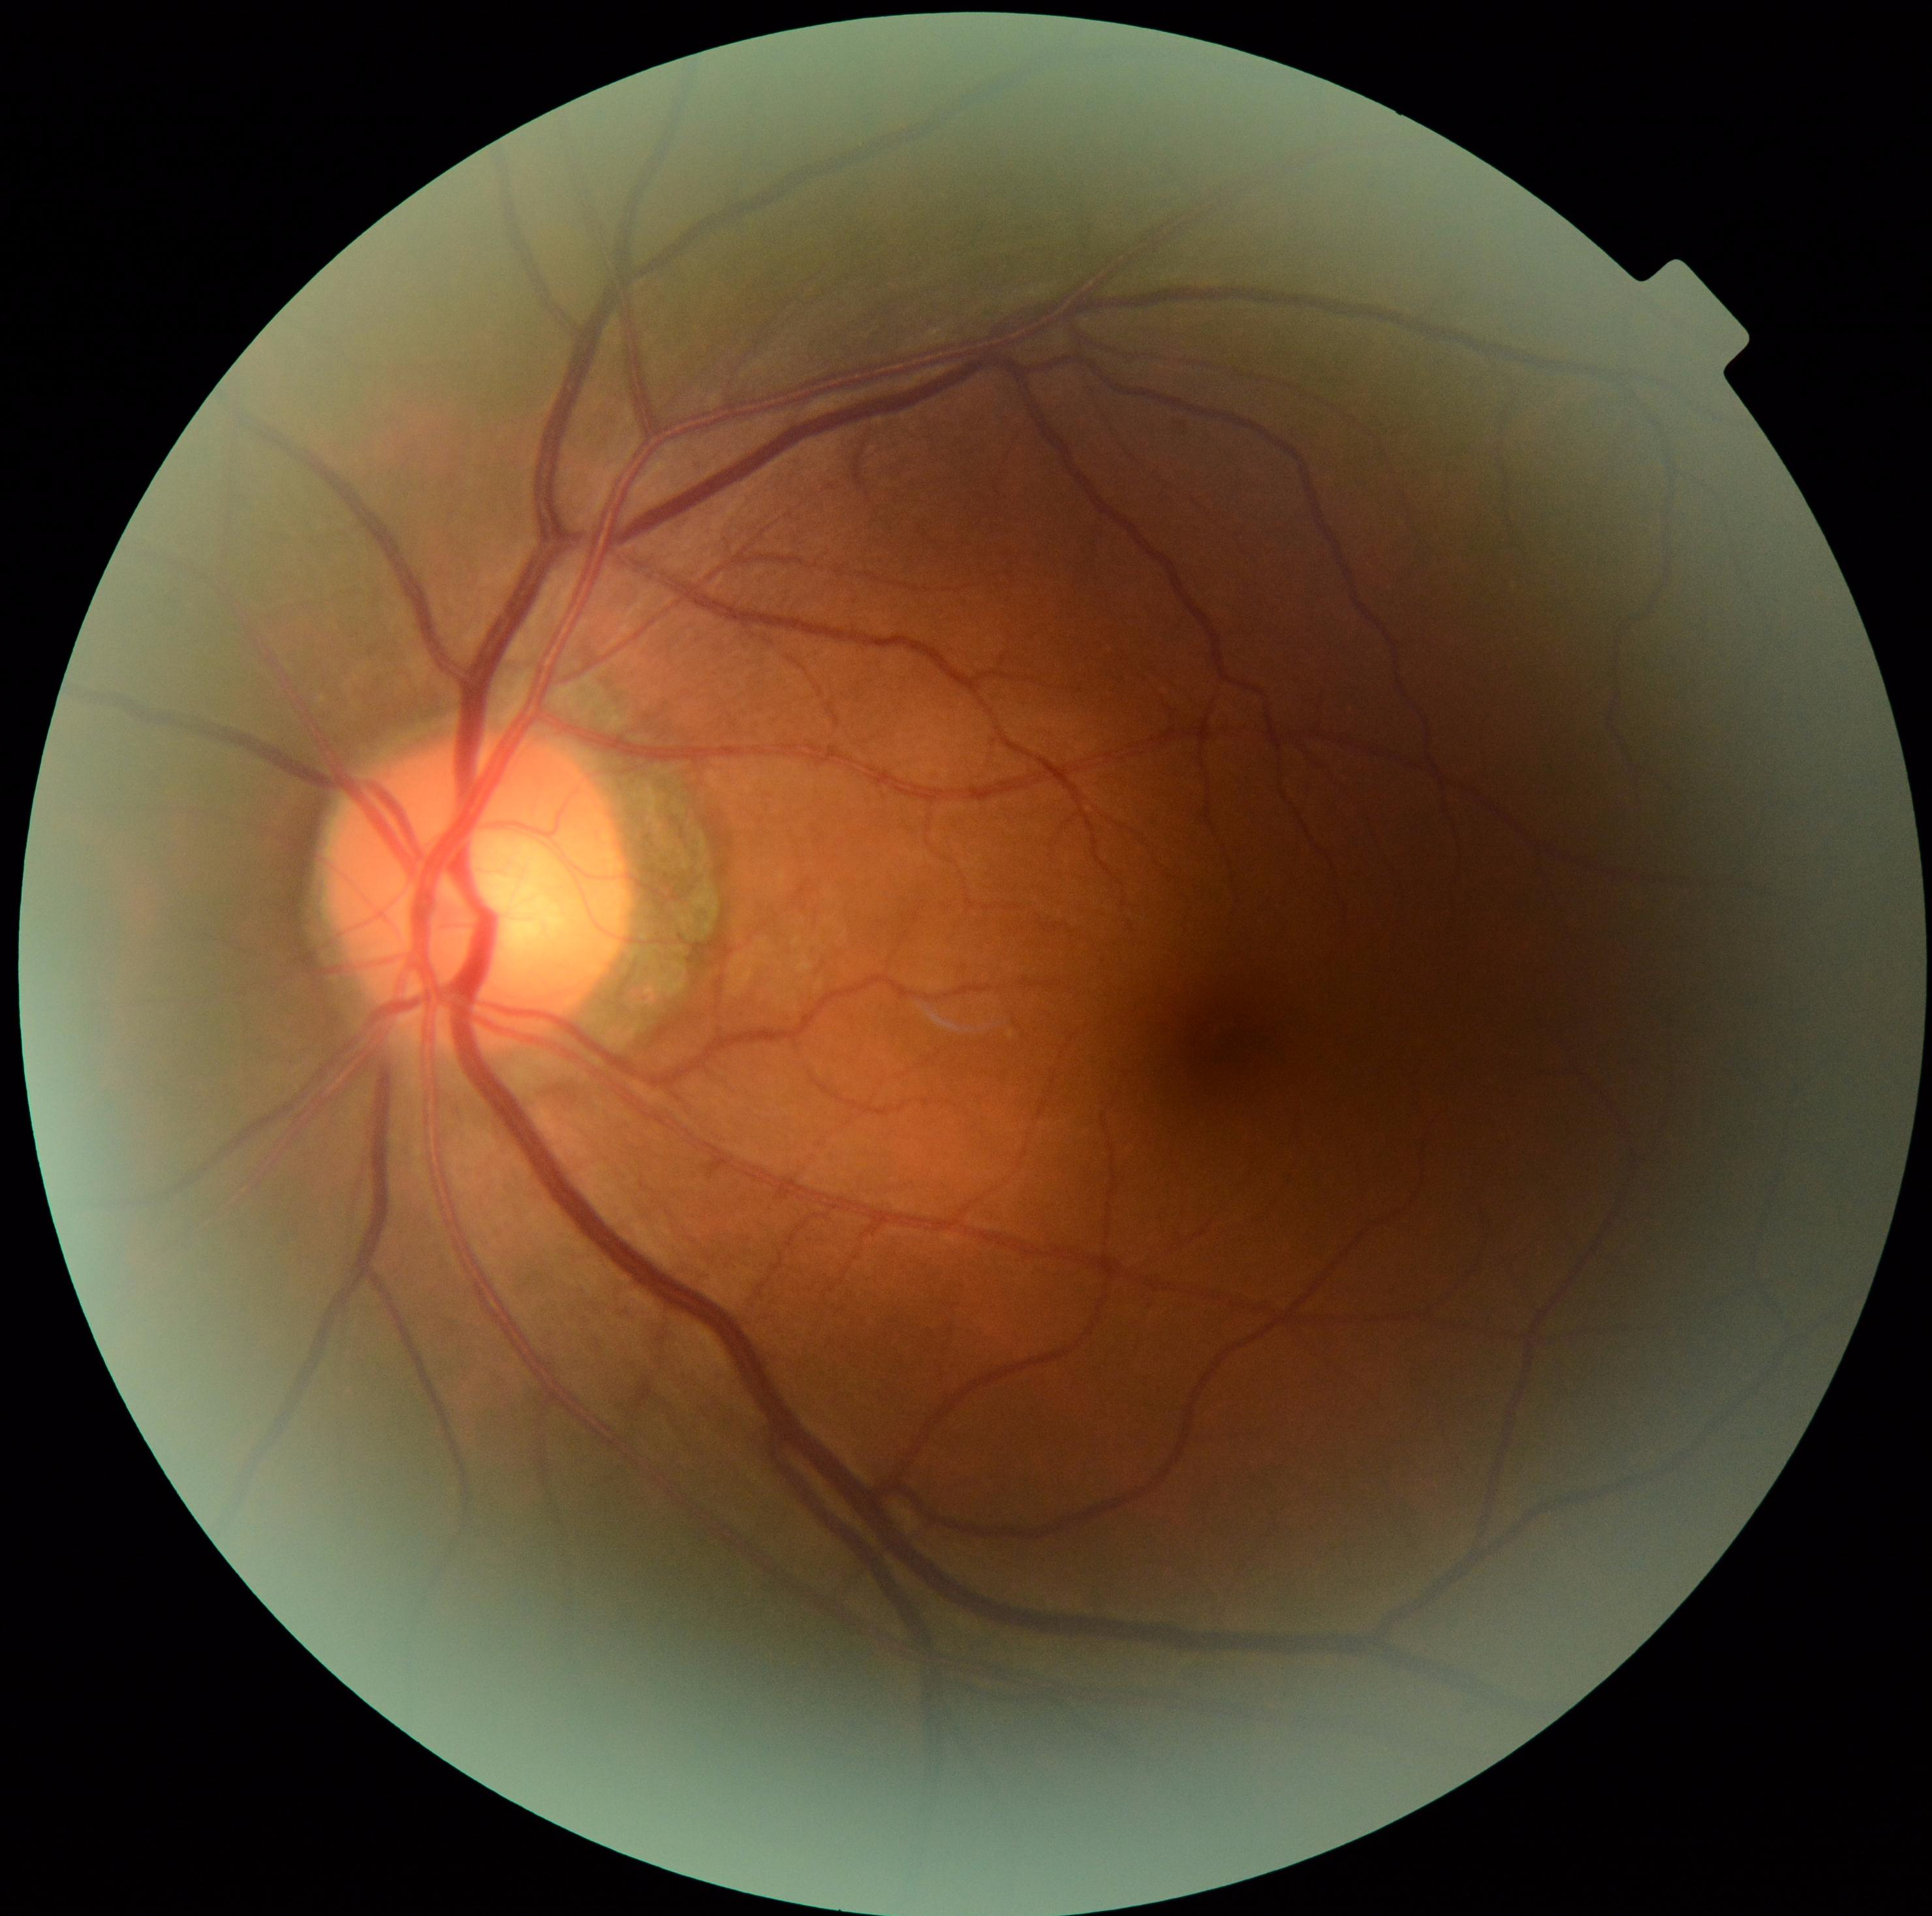 DR grade = no apparent retinopathy (0) | DR impression = no signs of DR.